Pediatric retinal photograph (wide-field).
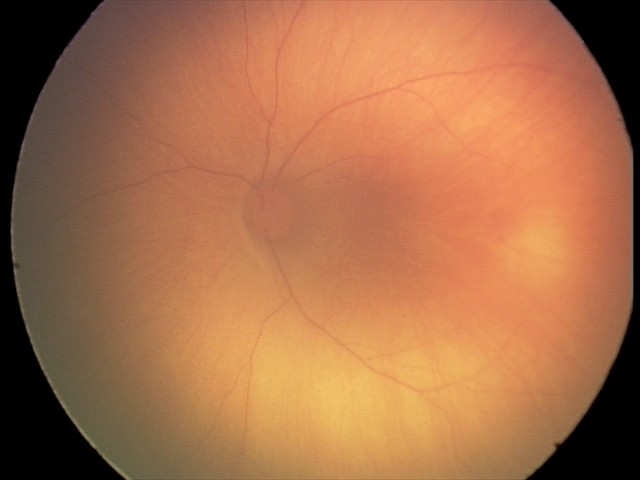

Series diagnosed as retinal hemorrhages.